Refraction: +1.5 -2.5 x 85 · female patient · 58 years old:
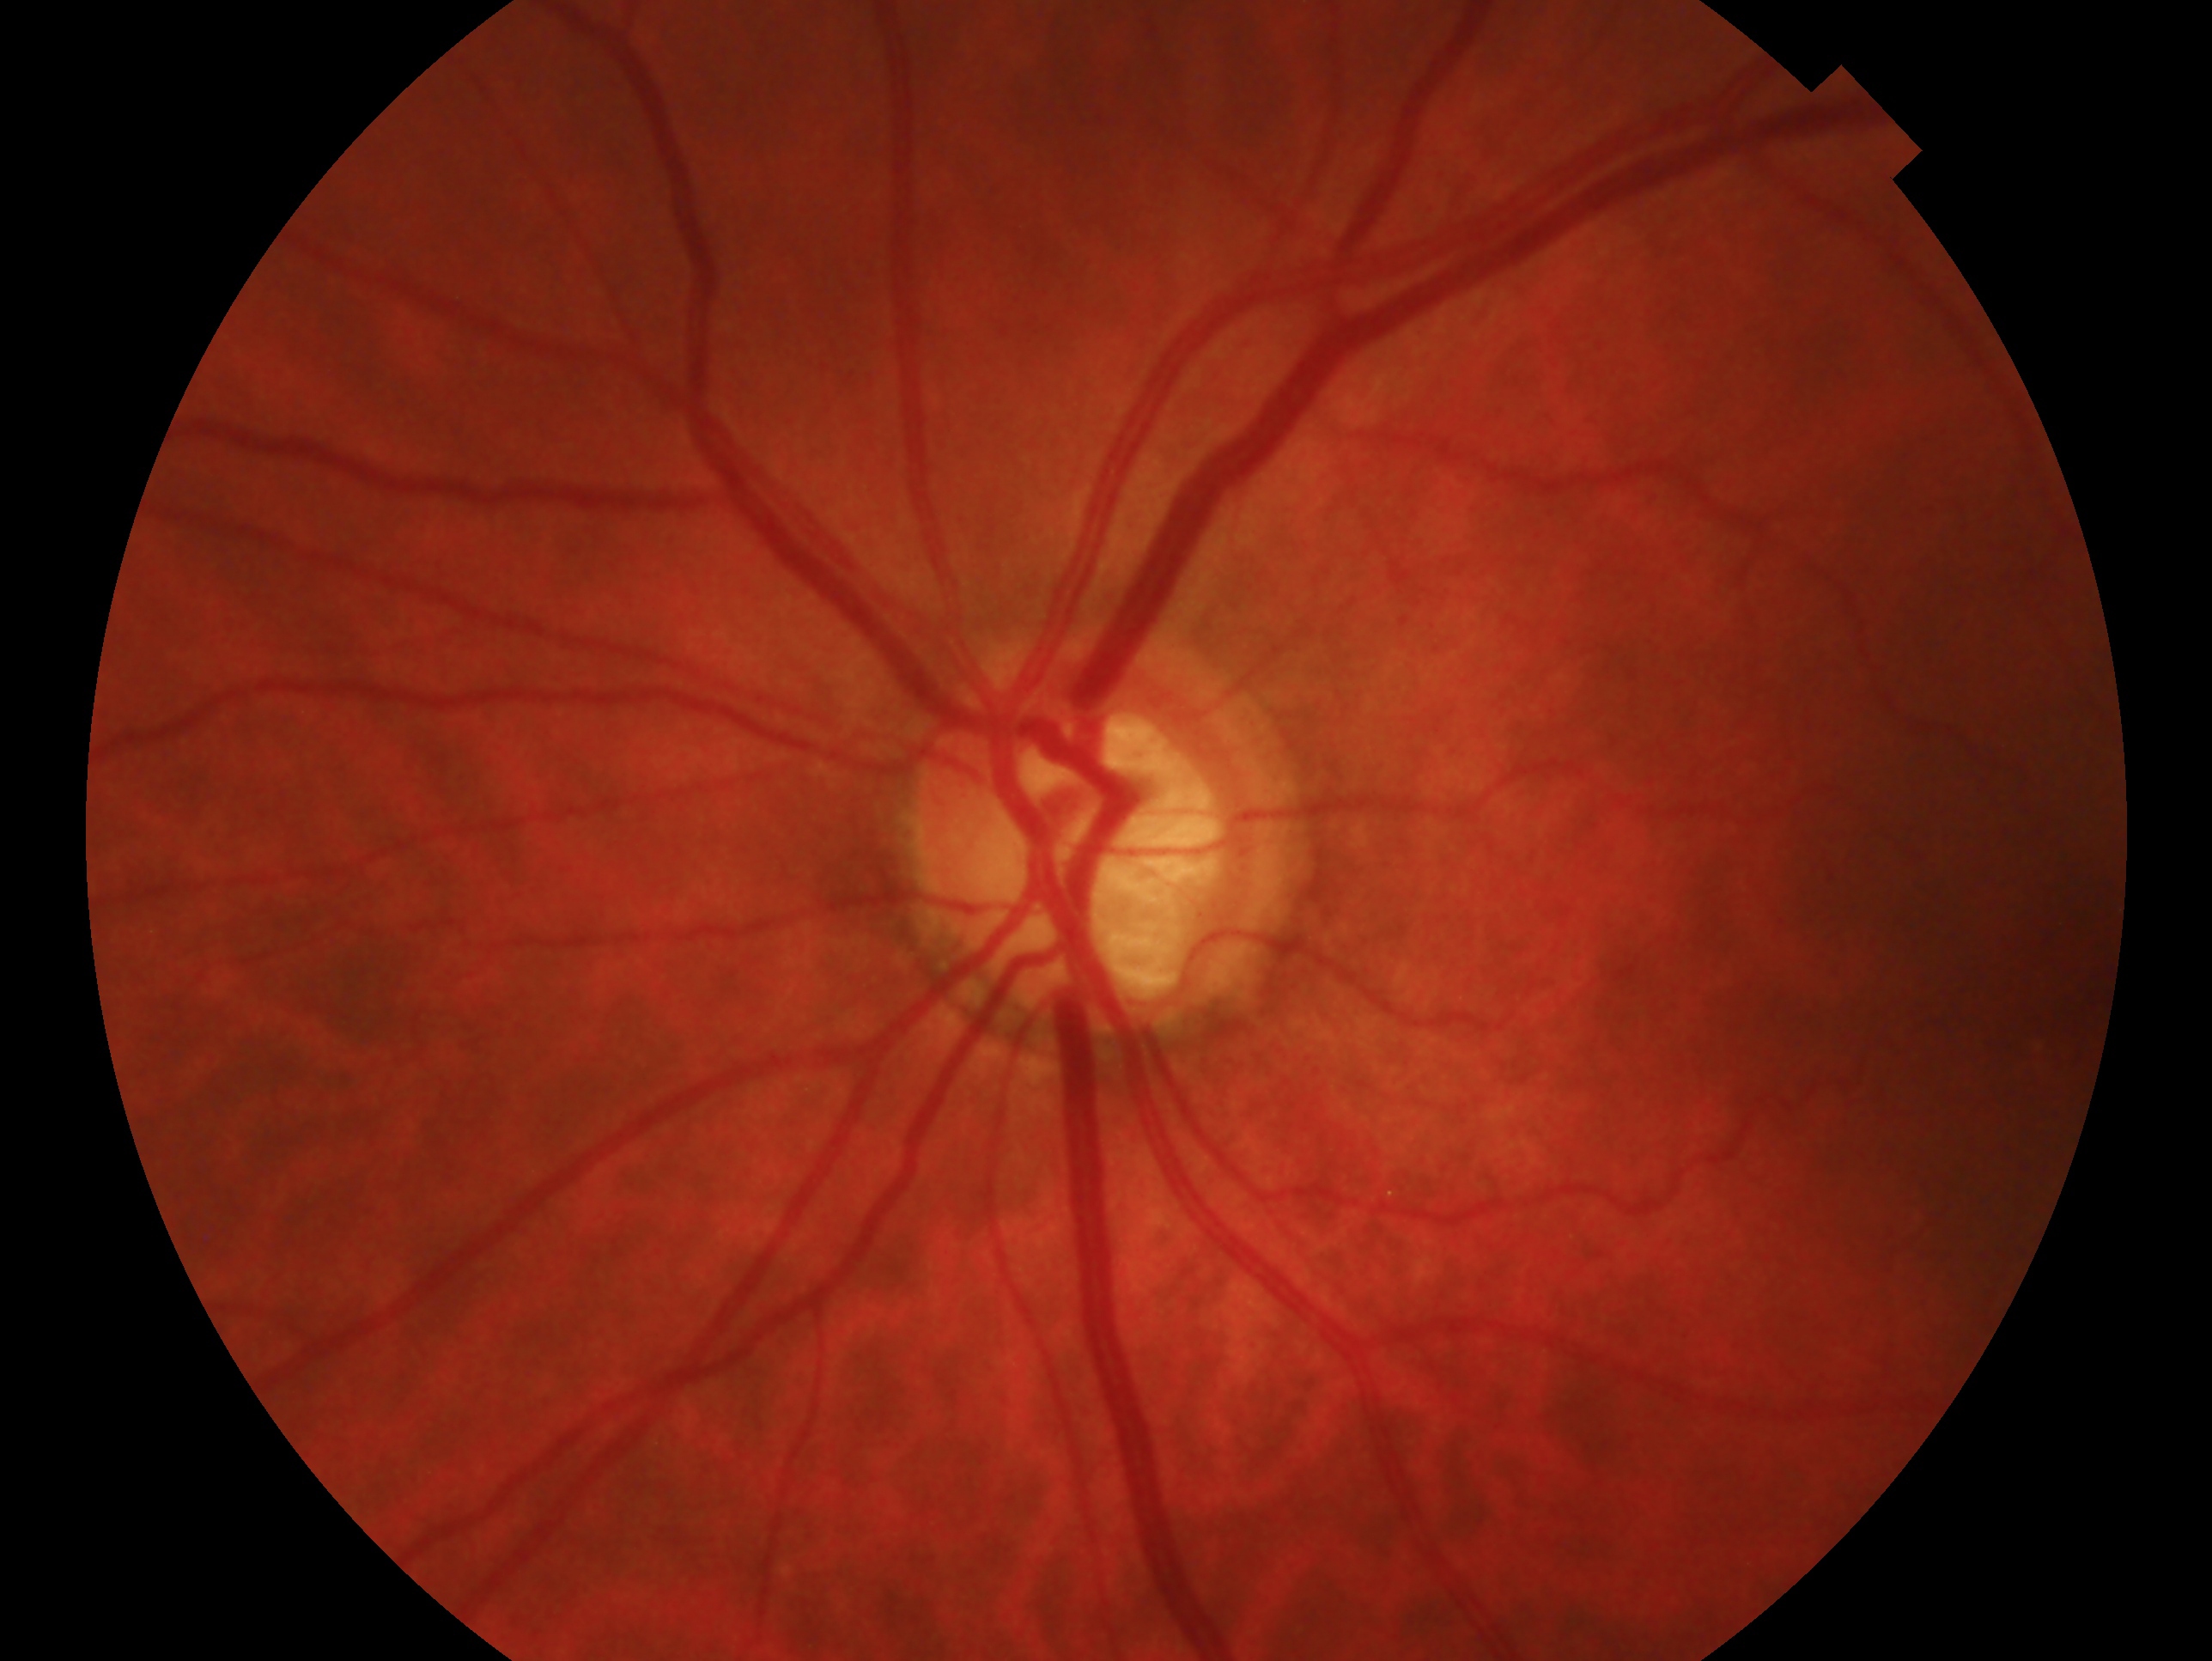
clinical classification = glaucoma, laterality = left.